Color fundus photograph: 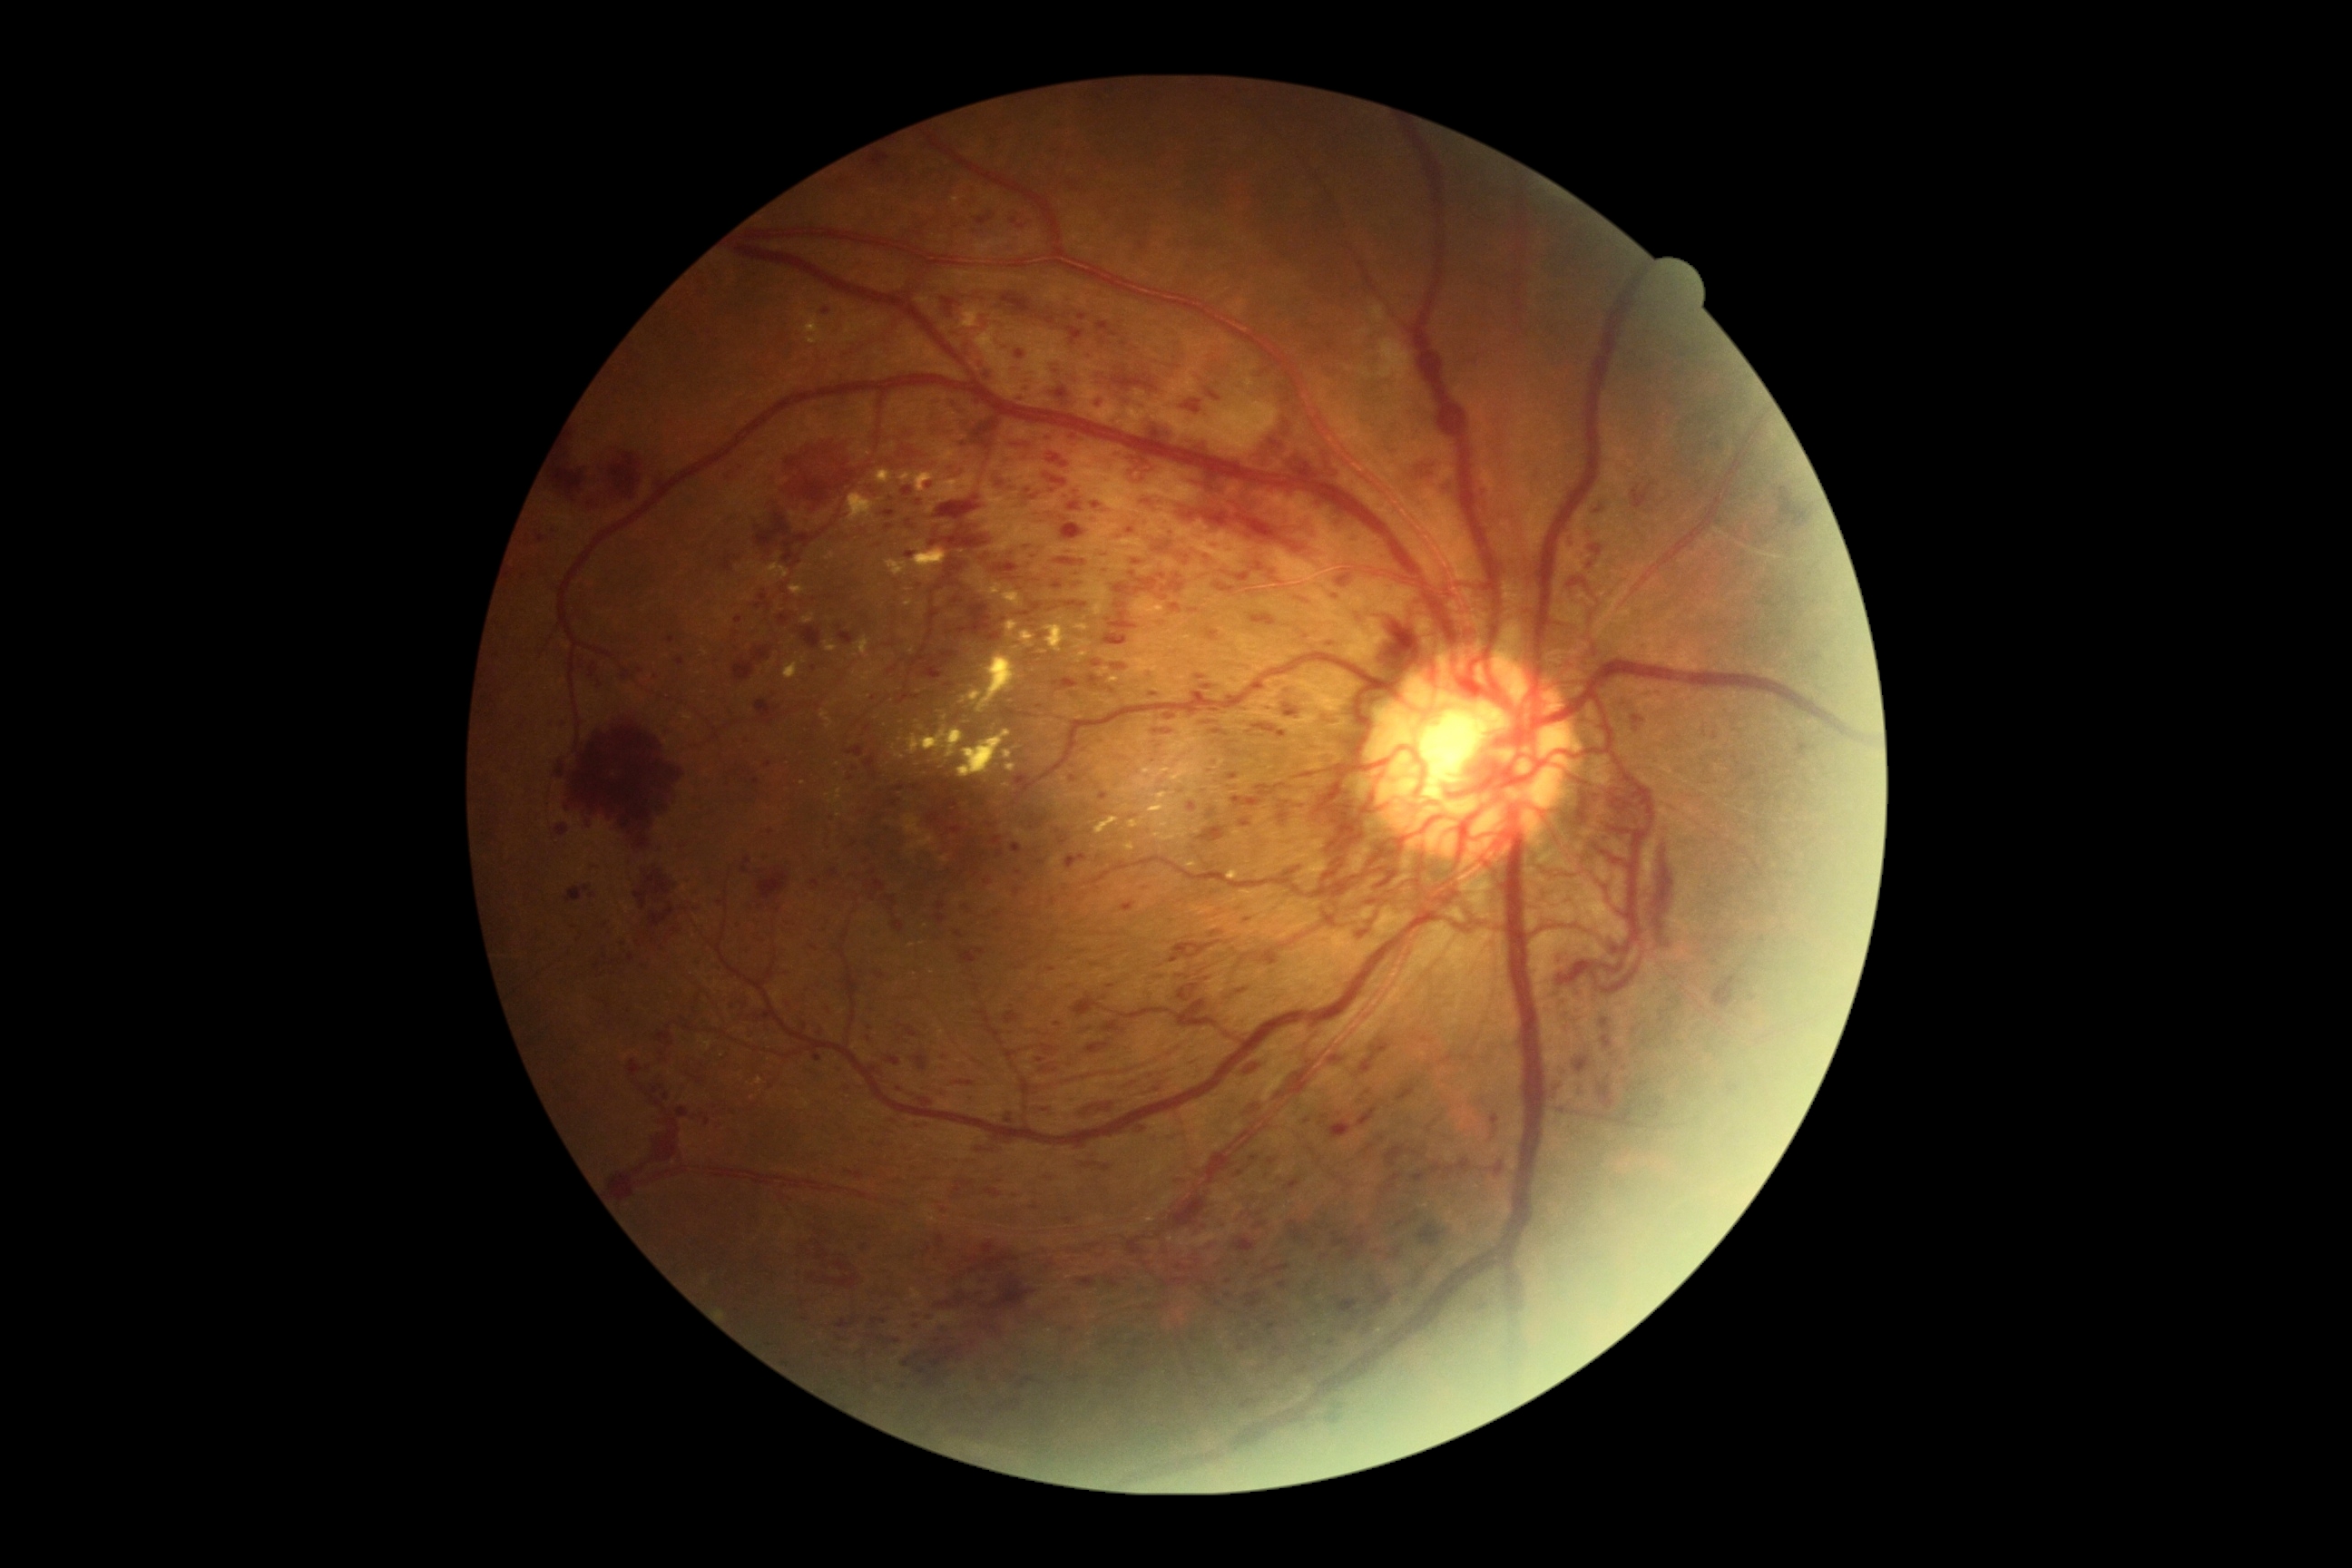 Diabetic retinopathy severity is 4/4; proliferative diabetic retinopathy
Selected lesions:
hemorrhages (subset) = BBox(1269, 571, 1280, 585); BBox(654, 1026, 674, 1048); BBox(1769, 487, 1812, 542); BBox(1090, 660, 1102, 667); BBox(972, 409, 1004, 451); BBox(1162, 1279, 1191, 1288); BBox(1101, 1166, 1112, 1173); BBox(936, 1300, 956, 1309); BBox(877, 1337, 885, 1340); BBox(954, 1179, 974, 1197); BBox(1386, 1146, 1424, 1168); BBox(847, 745, 863, 758); BBox(1729, 1084, 1740, 1095); BBox(578, 660, 583, 671); BBox(1066, 328, 1084, 344); BBox(1257, 1264, 1291, 1280)
Small hemorrhages near [x=768, y=766]; [x=1645, y=1043]; [x=1623, y=1070]